Wide-field fundus photograph from neonatal ROP screening.
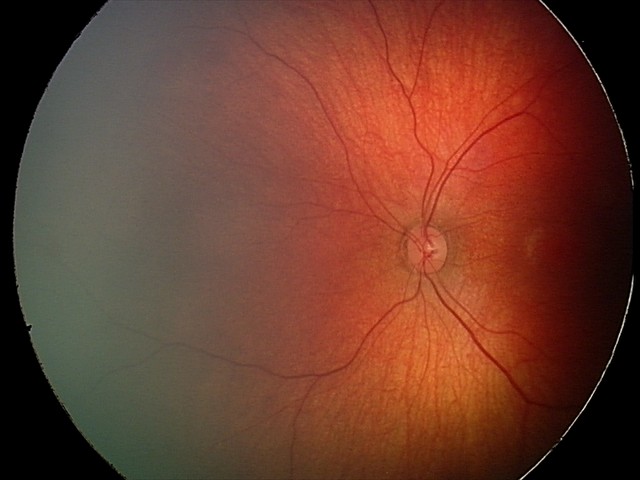

From an examination with diagnosis of retinal hemorrhages.